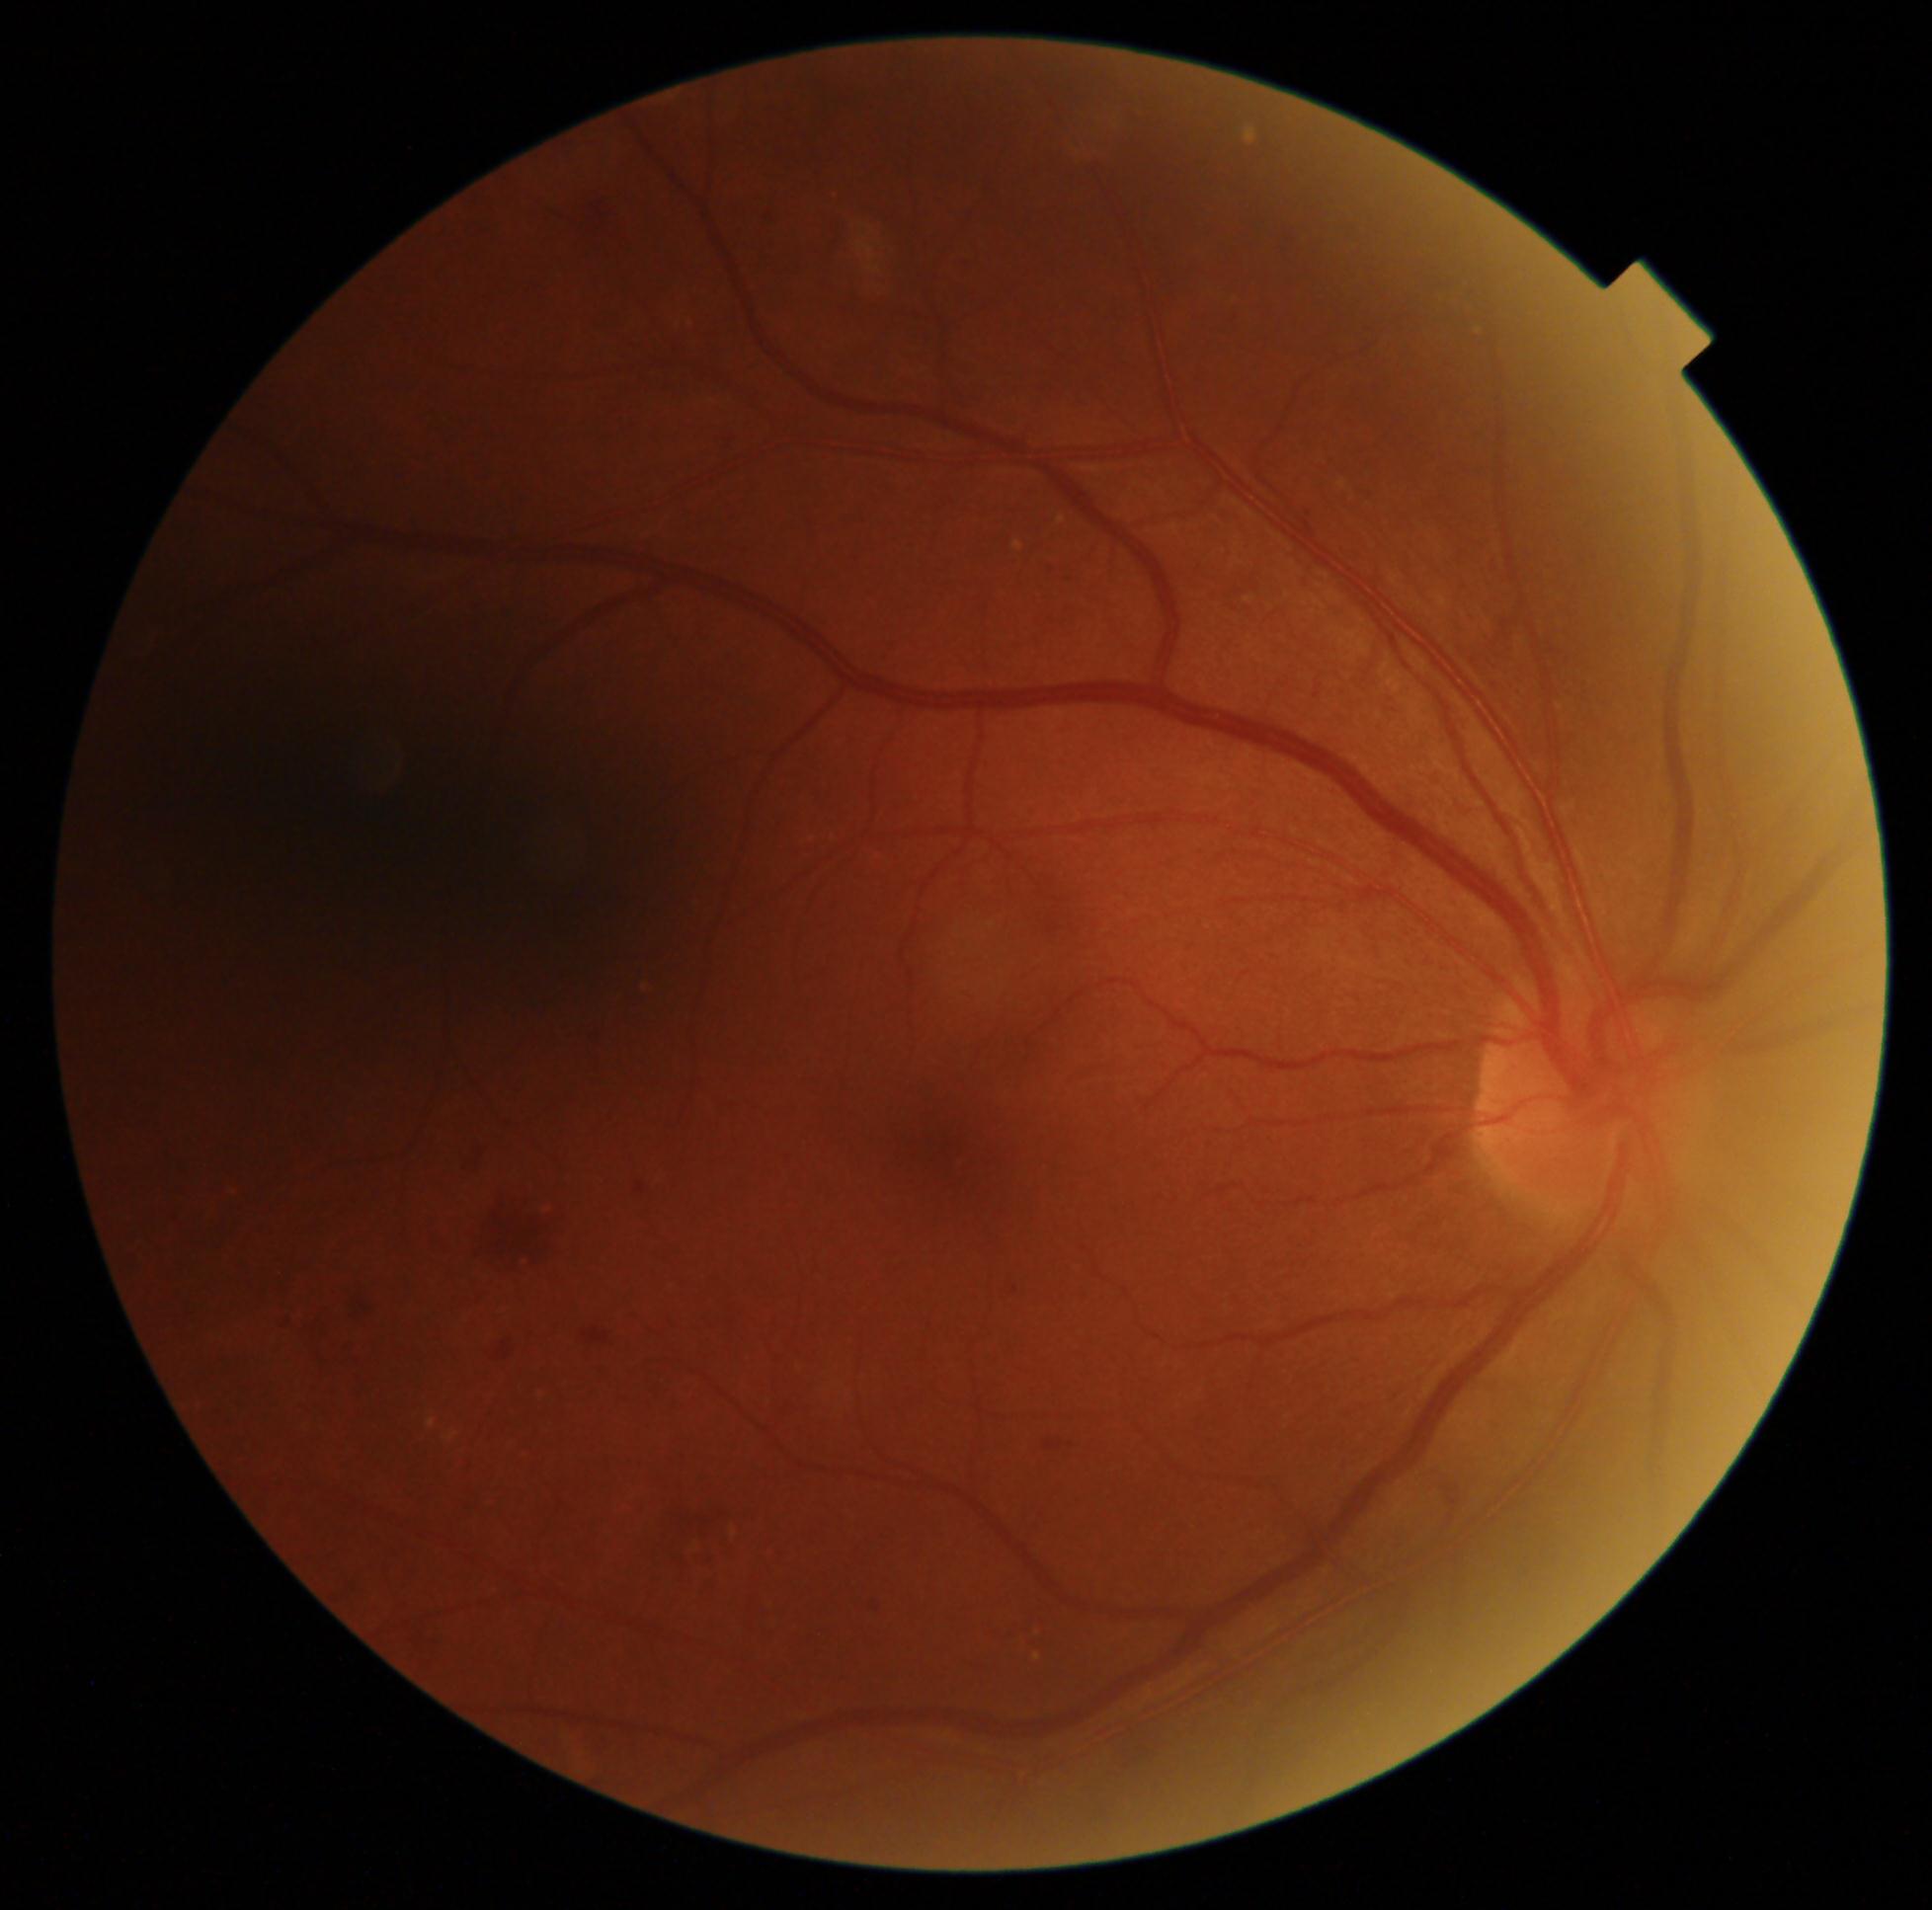

dr_grade: grade 2 (moderate NPDR)